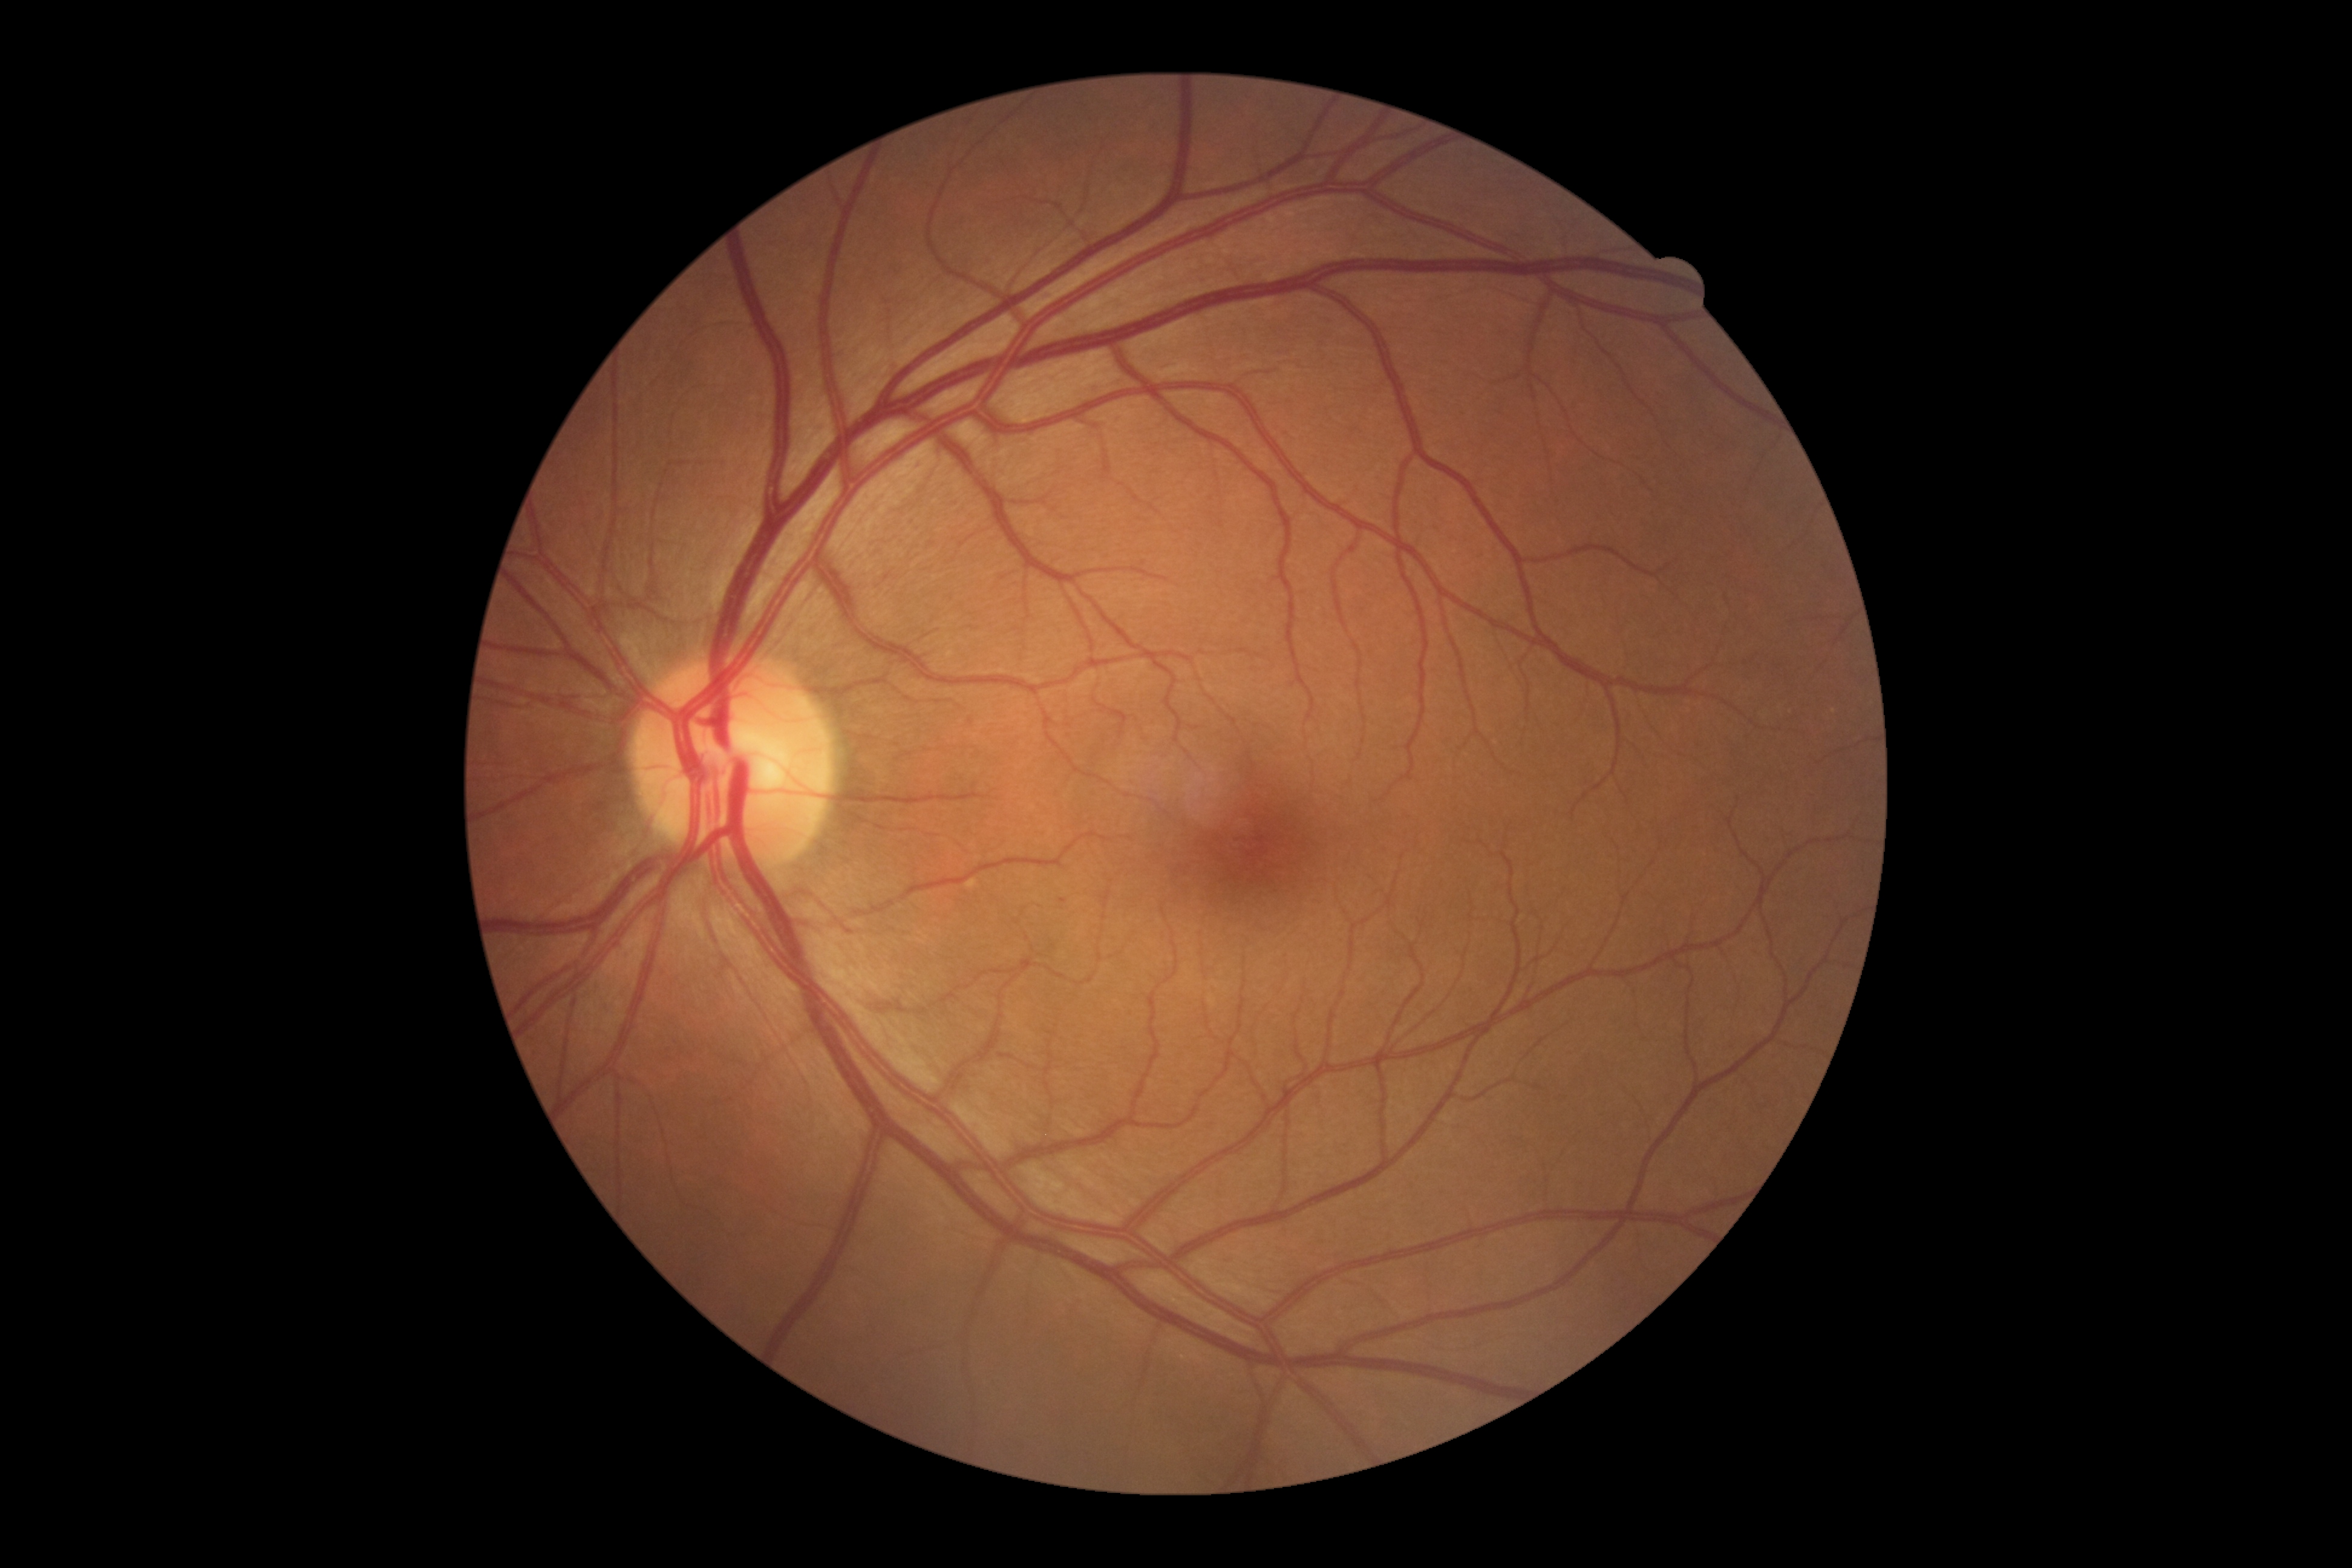
DR severity: no apparent diabetic retinopathy (grade 0).
No signs of diabetic retinopathy.